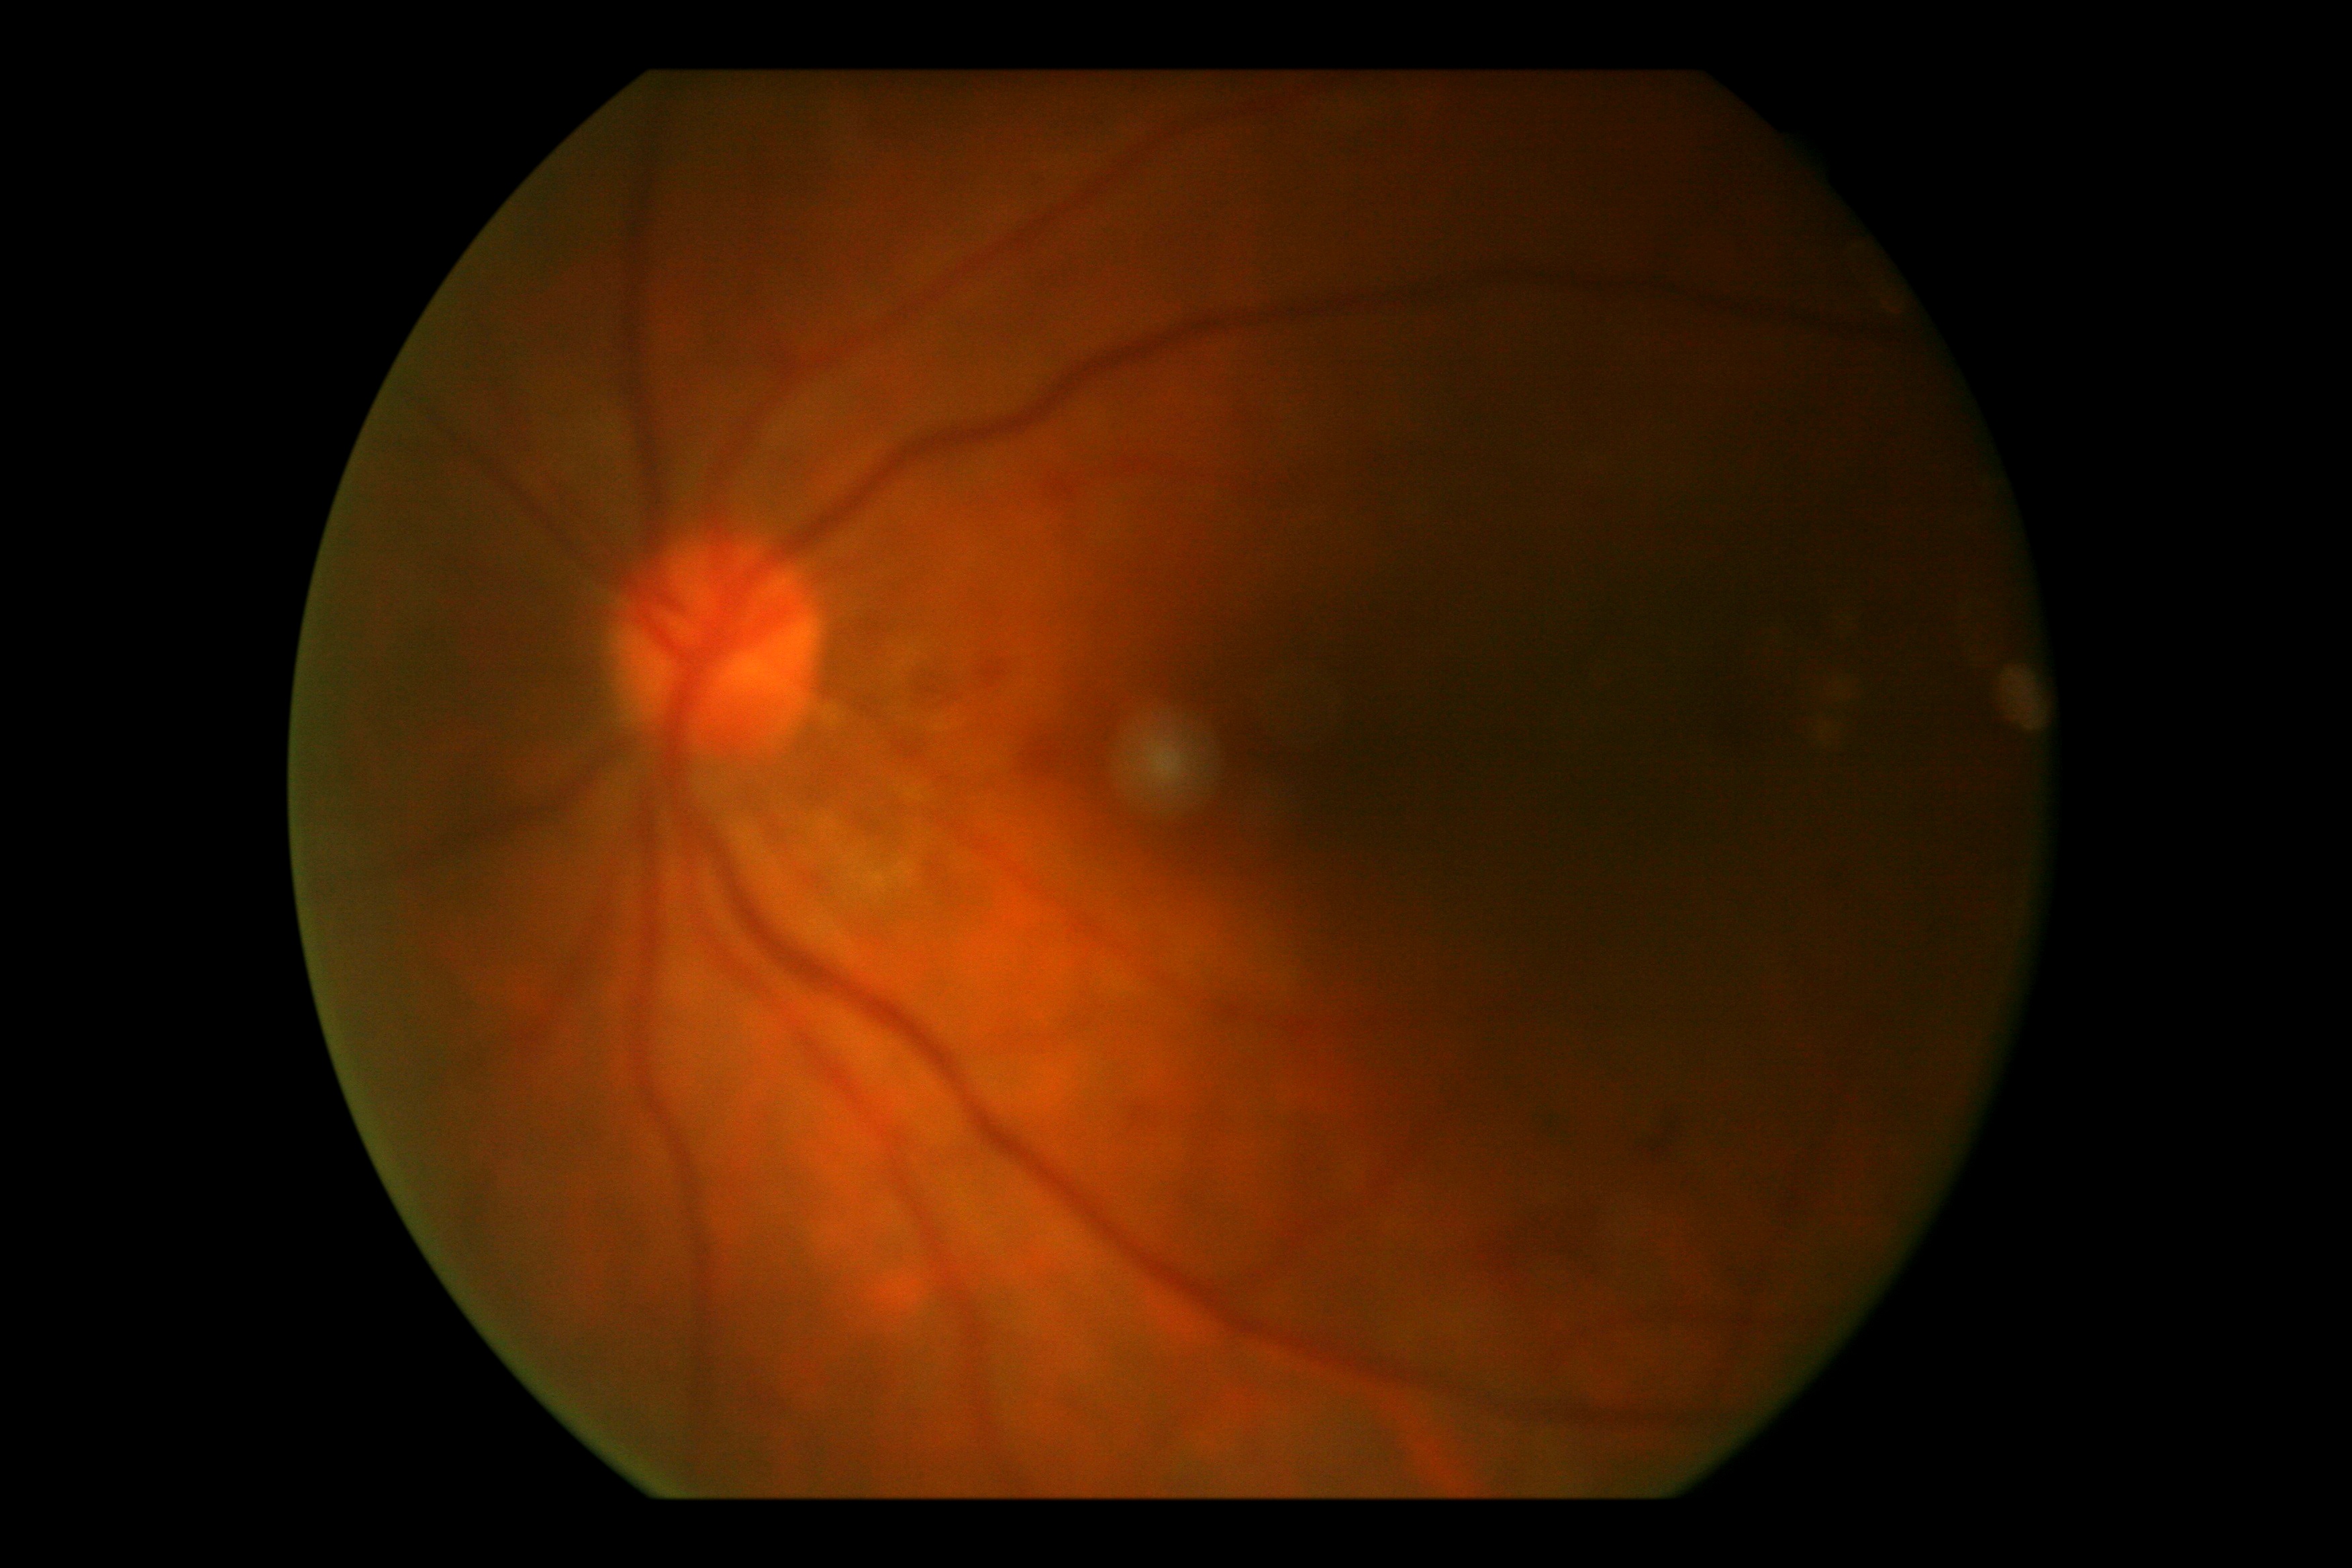
Findings:
- diabetic retinopathy: moderate non-proliferative diabetic retinopathy (grade 2)
- DR class: non-proliferative diabetic retinopathy